2048 by 1536 pixels. 45° field of view. Fundus photo:
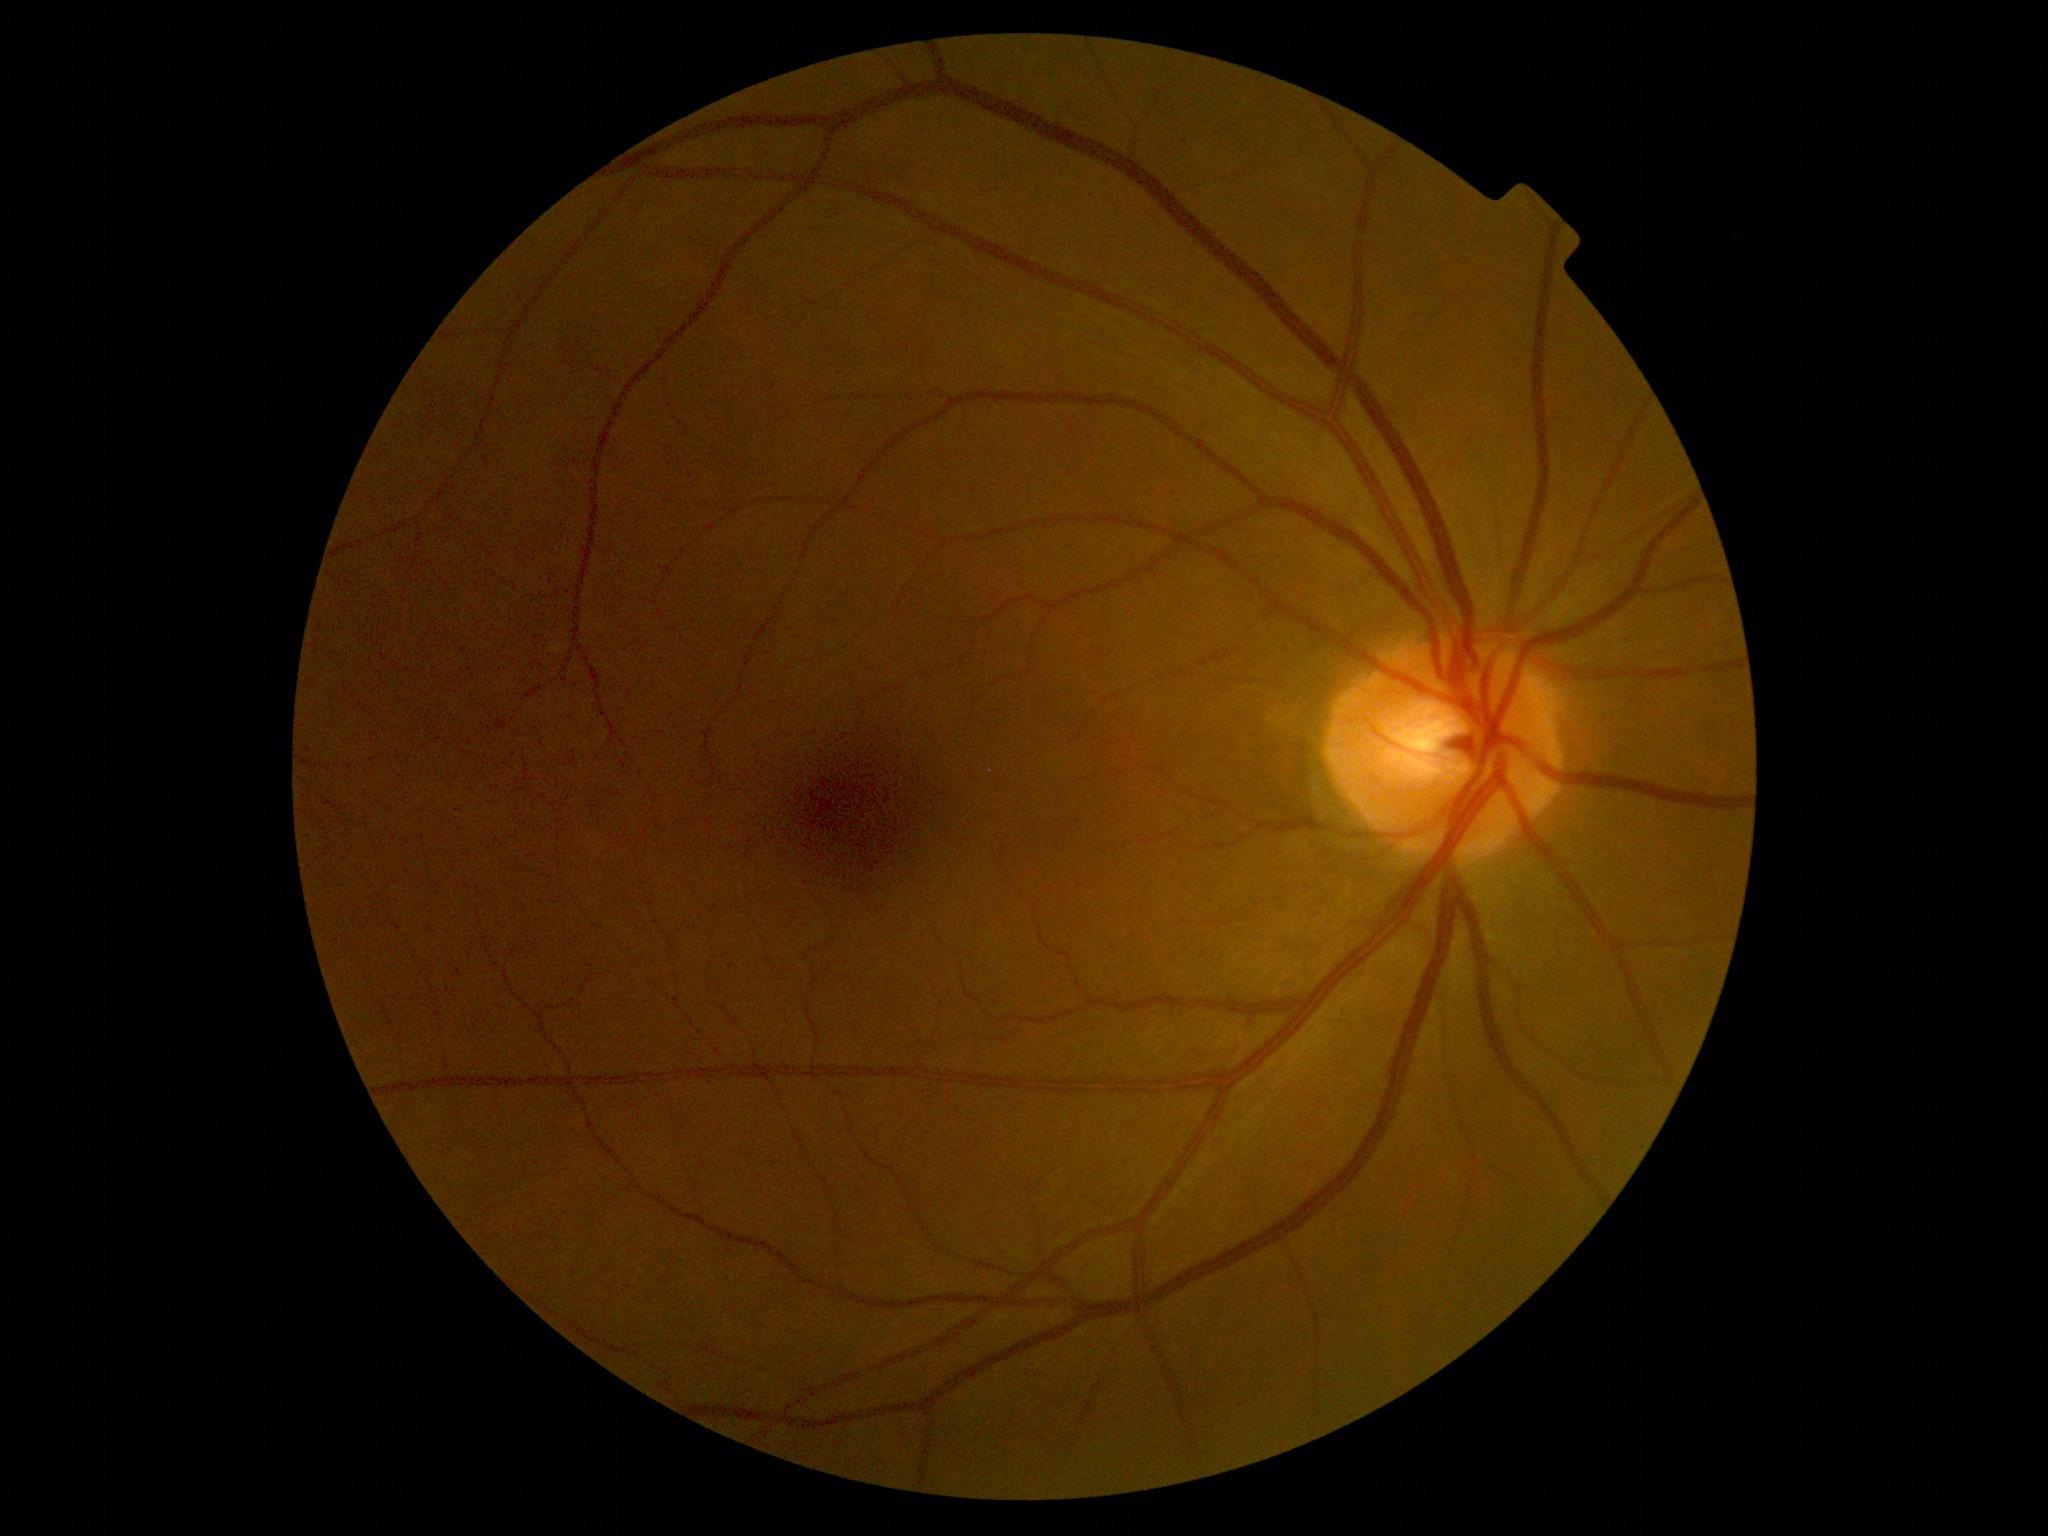
retinopathy=grade 0, DR impression=no apparent DR.